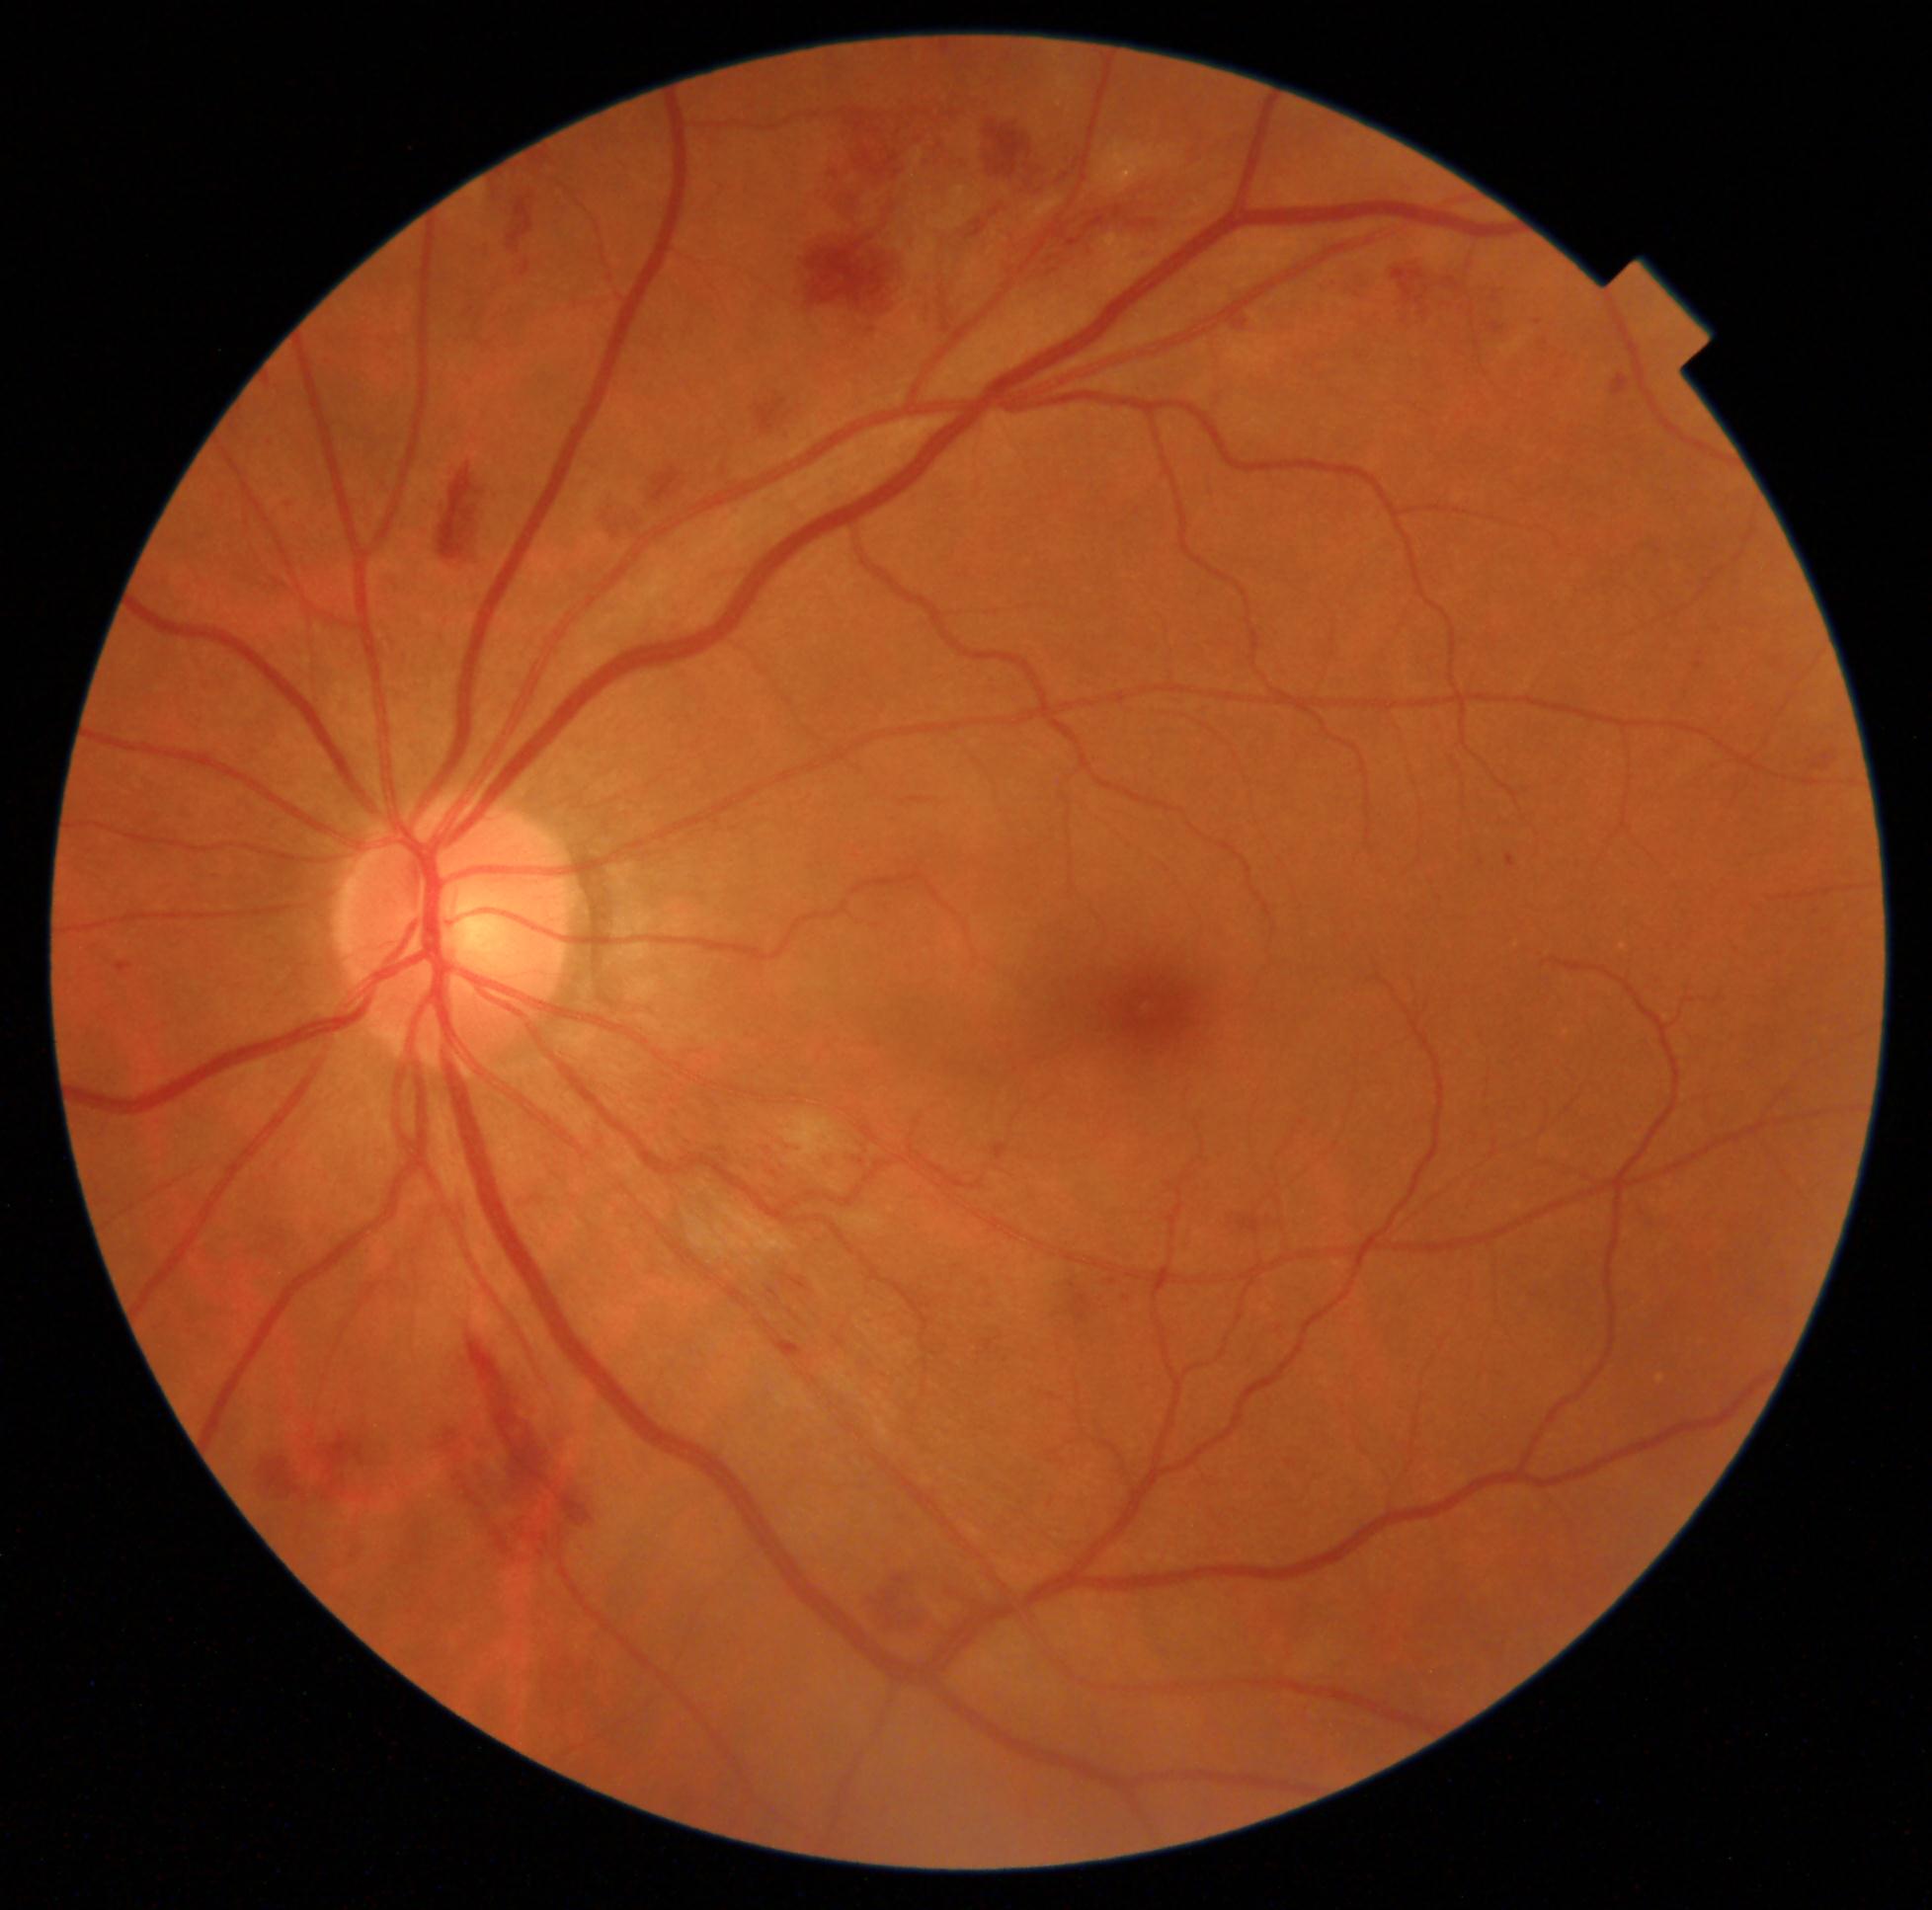
DR stage is 2.